2352 by 1568 pixels, CFP:
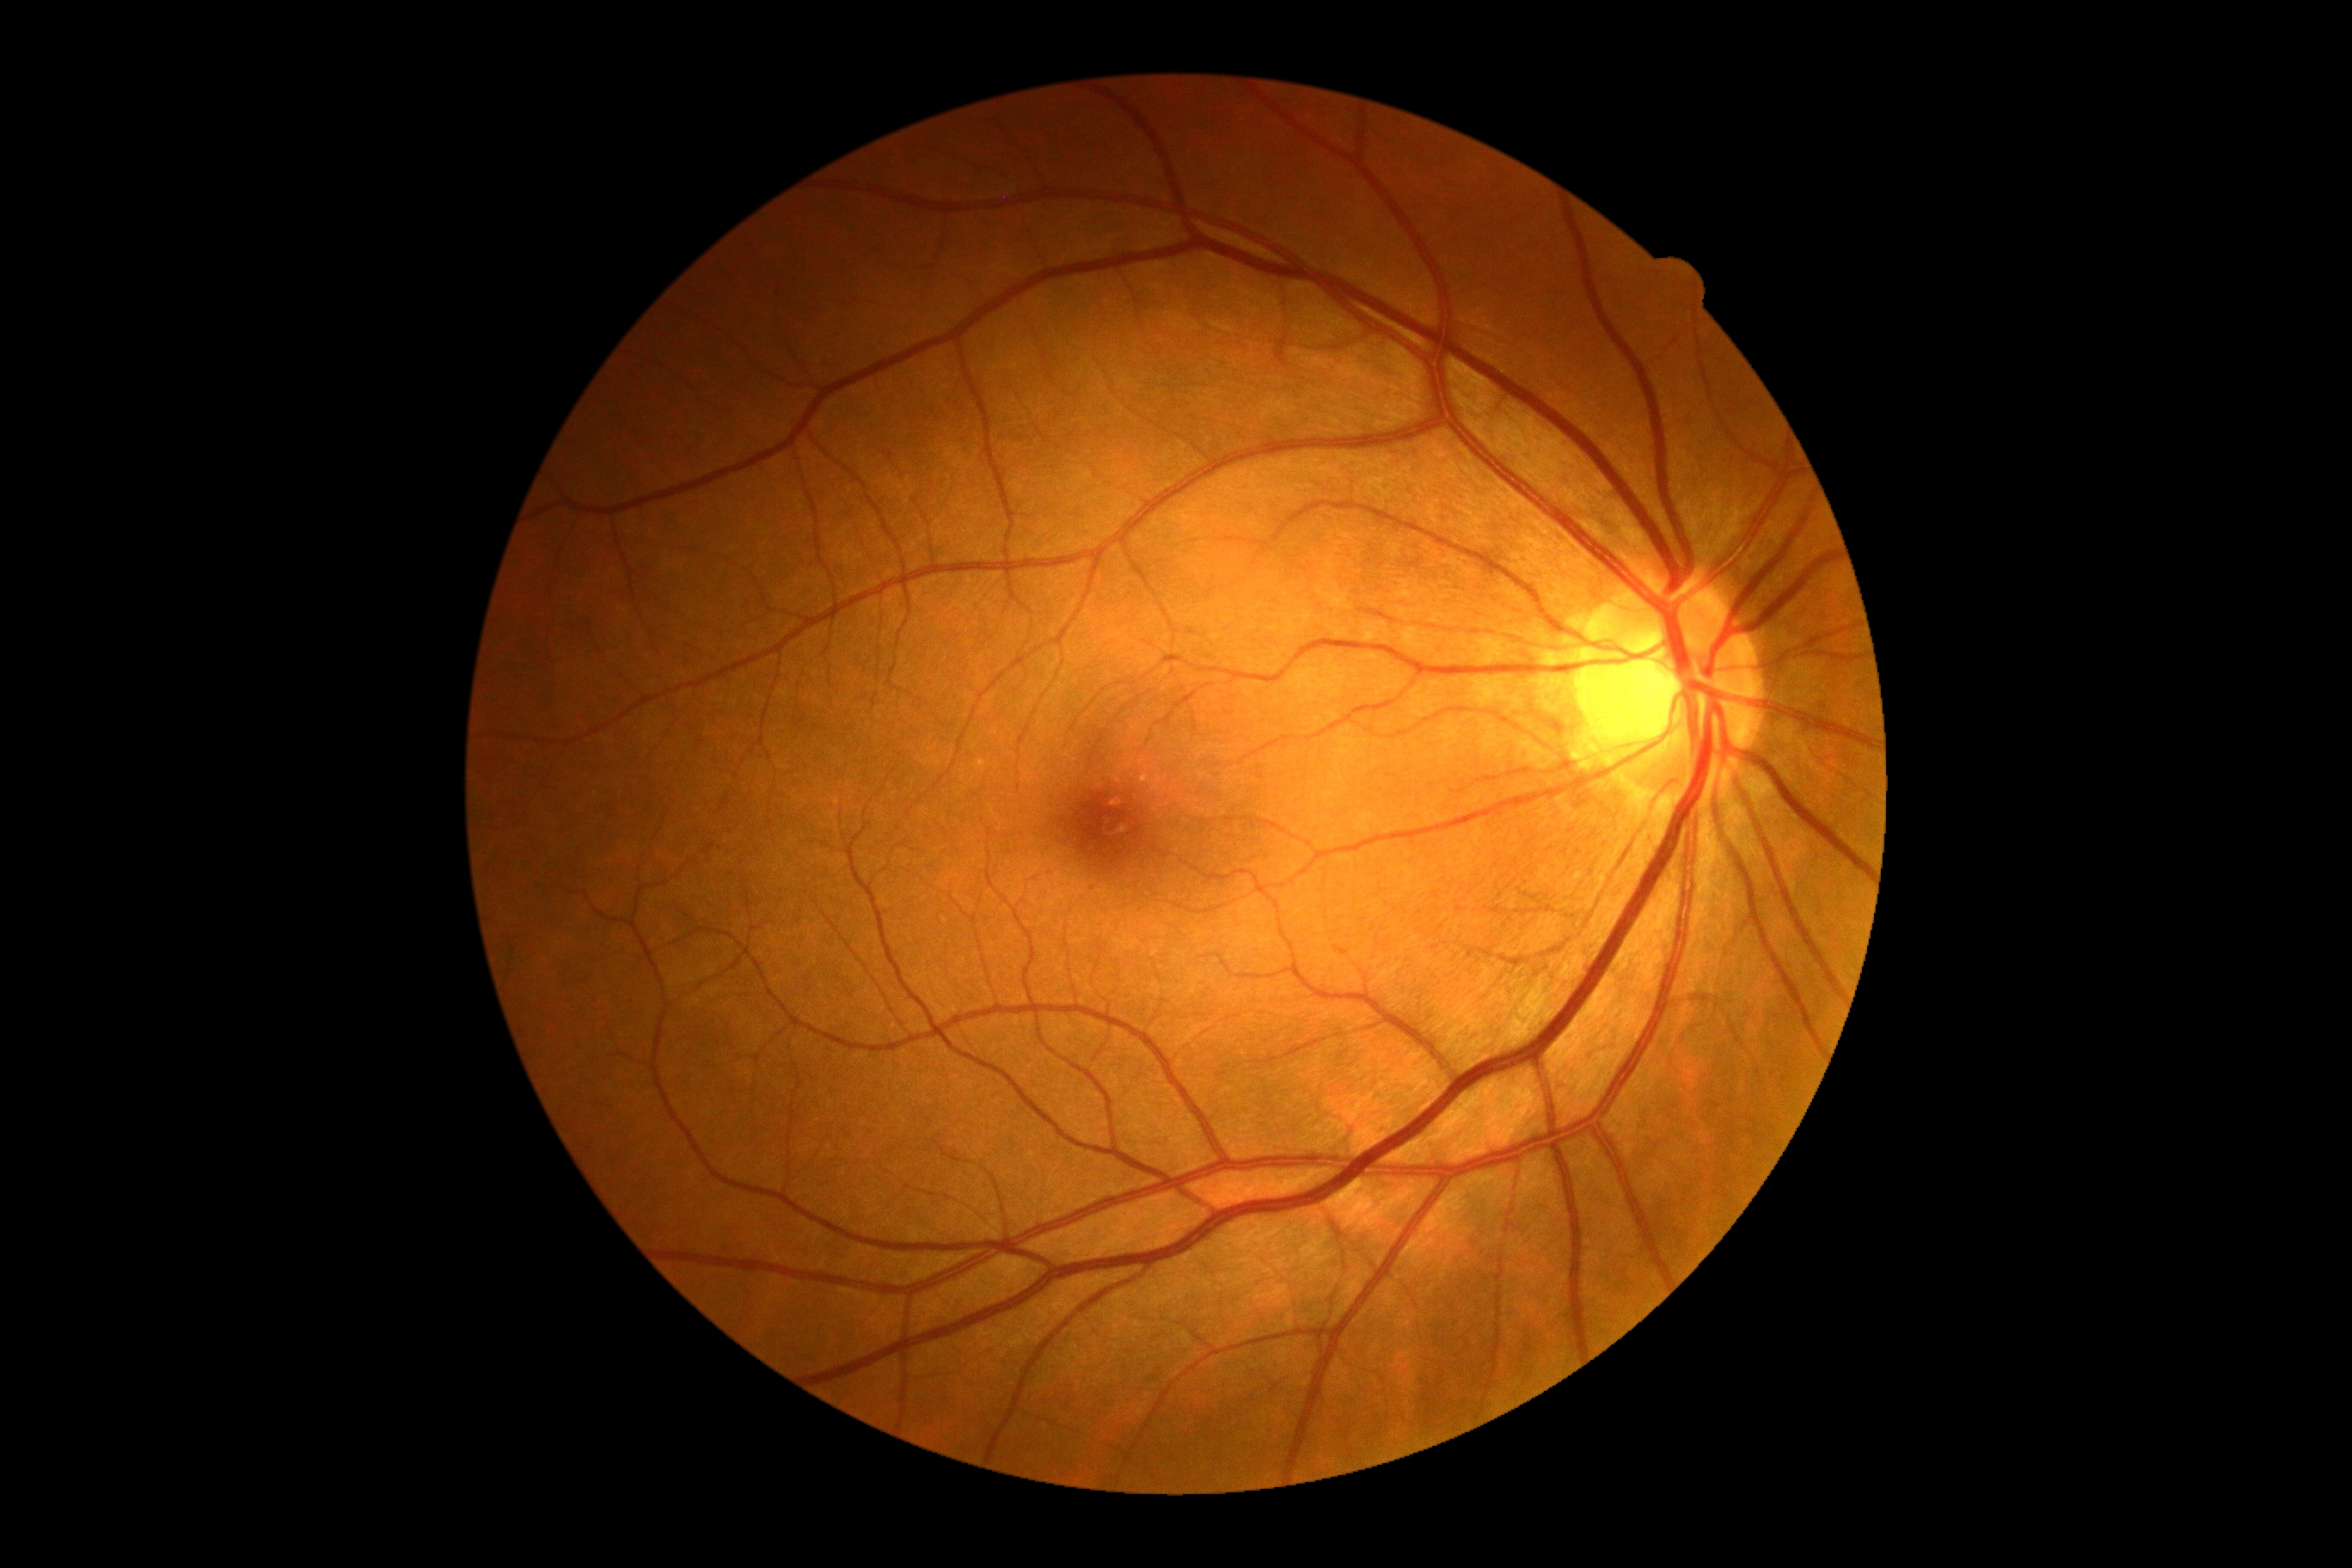 DR grade: 0.